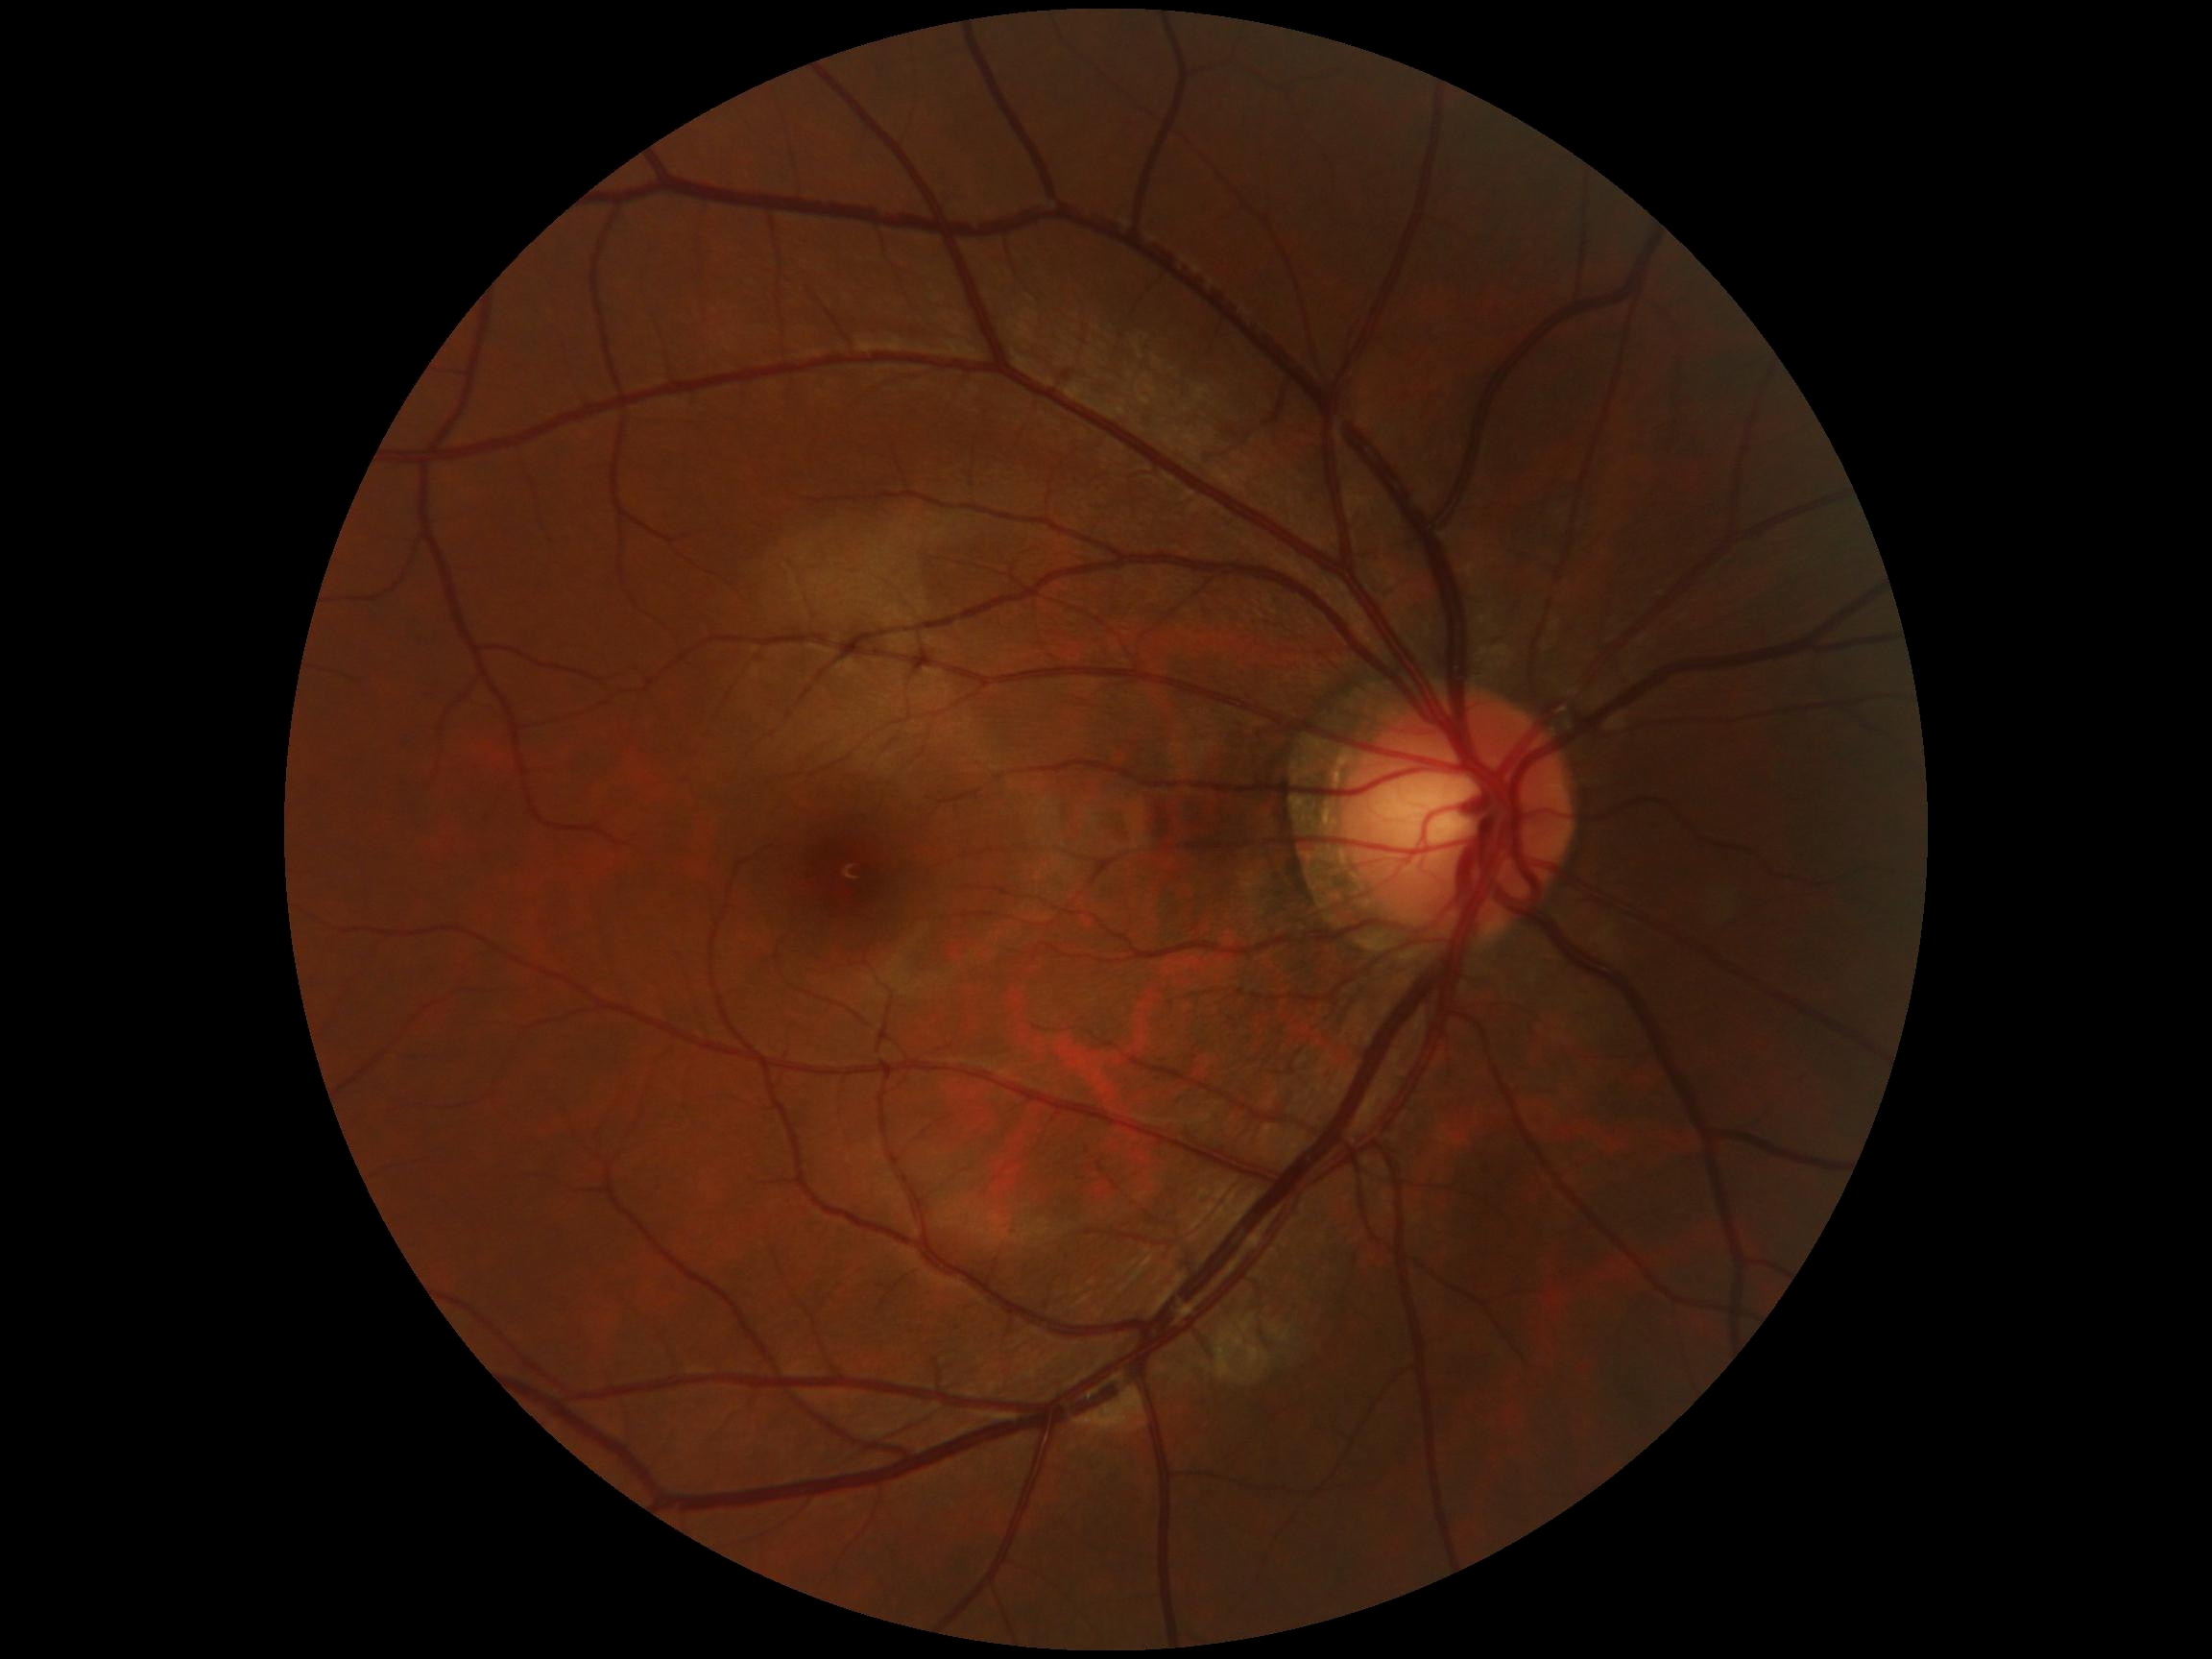

Diabetic retinopathy severity is no apparent retinopathy (grade 0) — no visible signs of diabetic retinopathy.